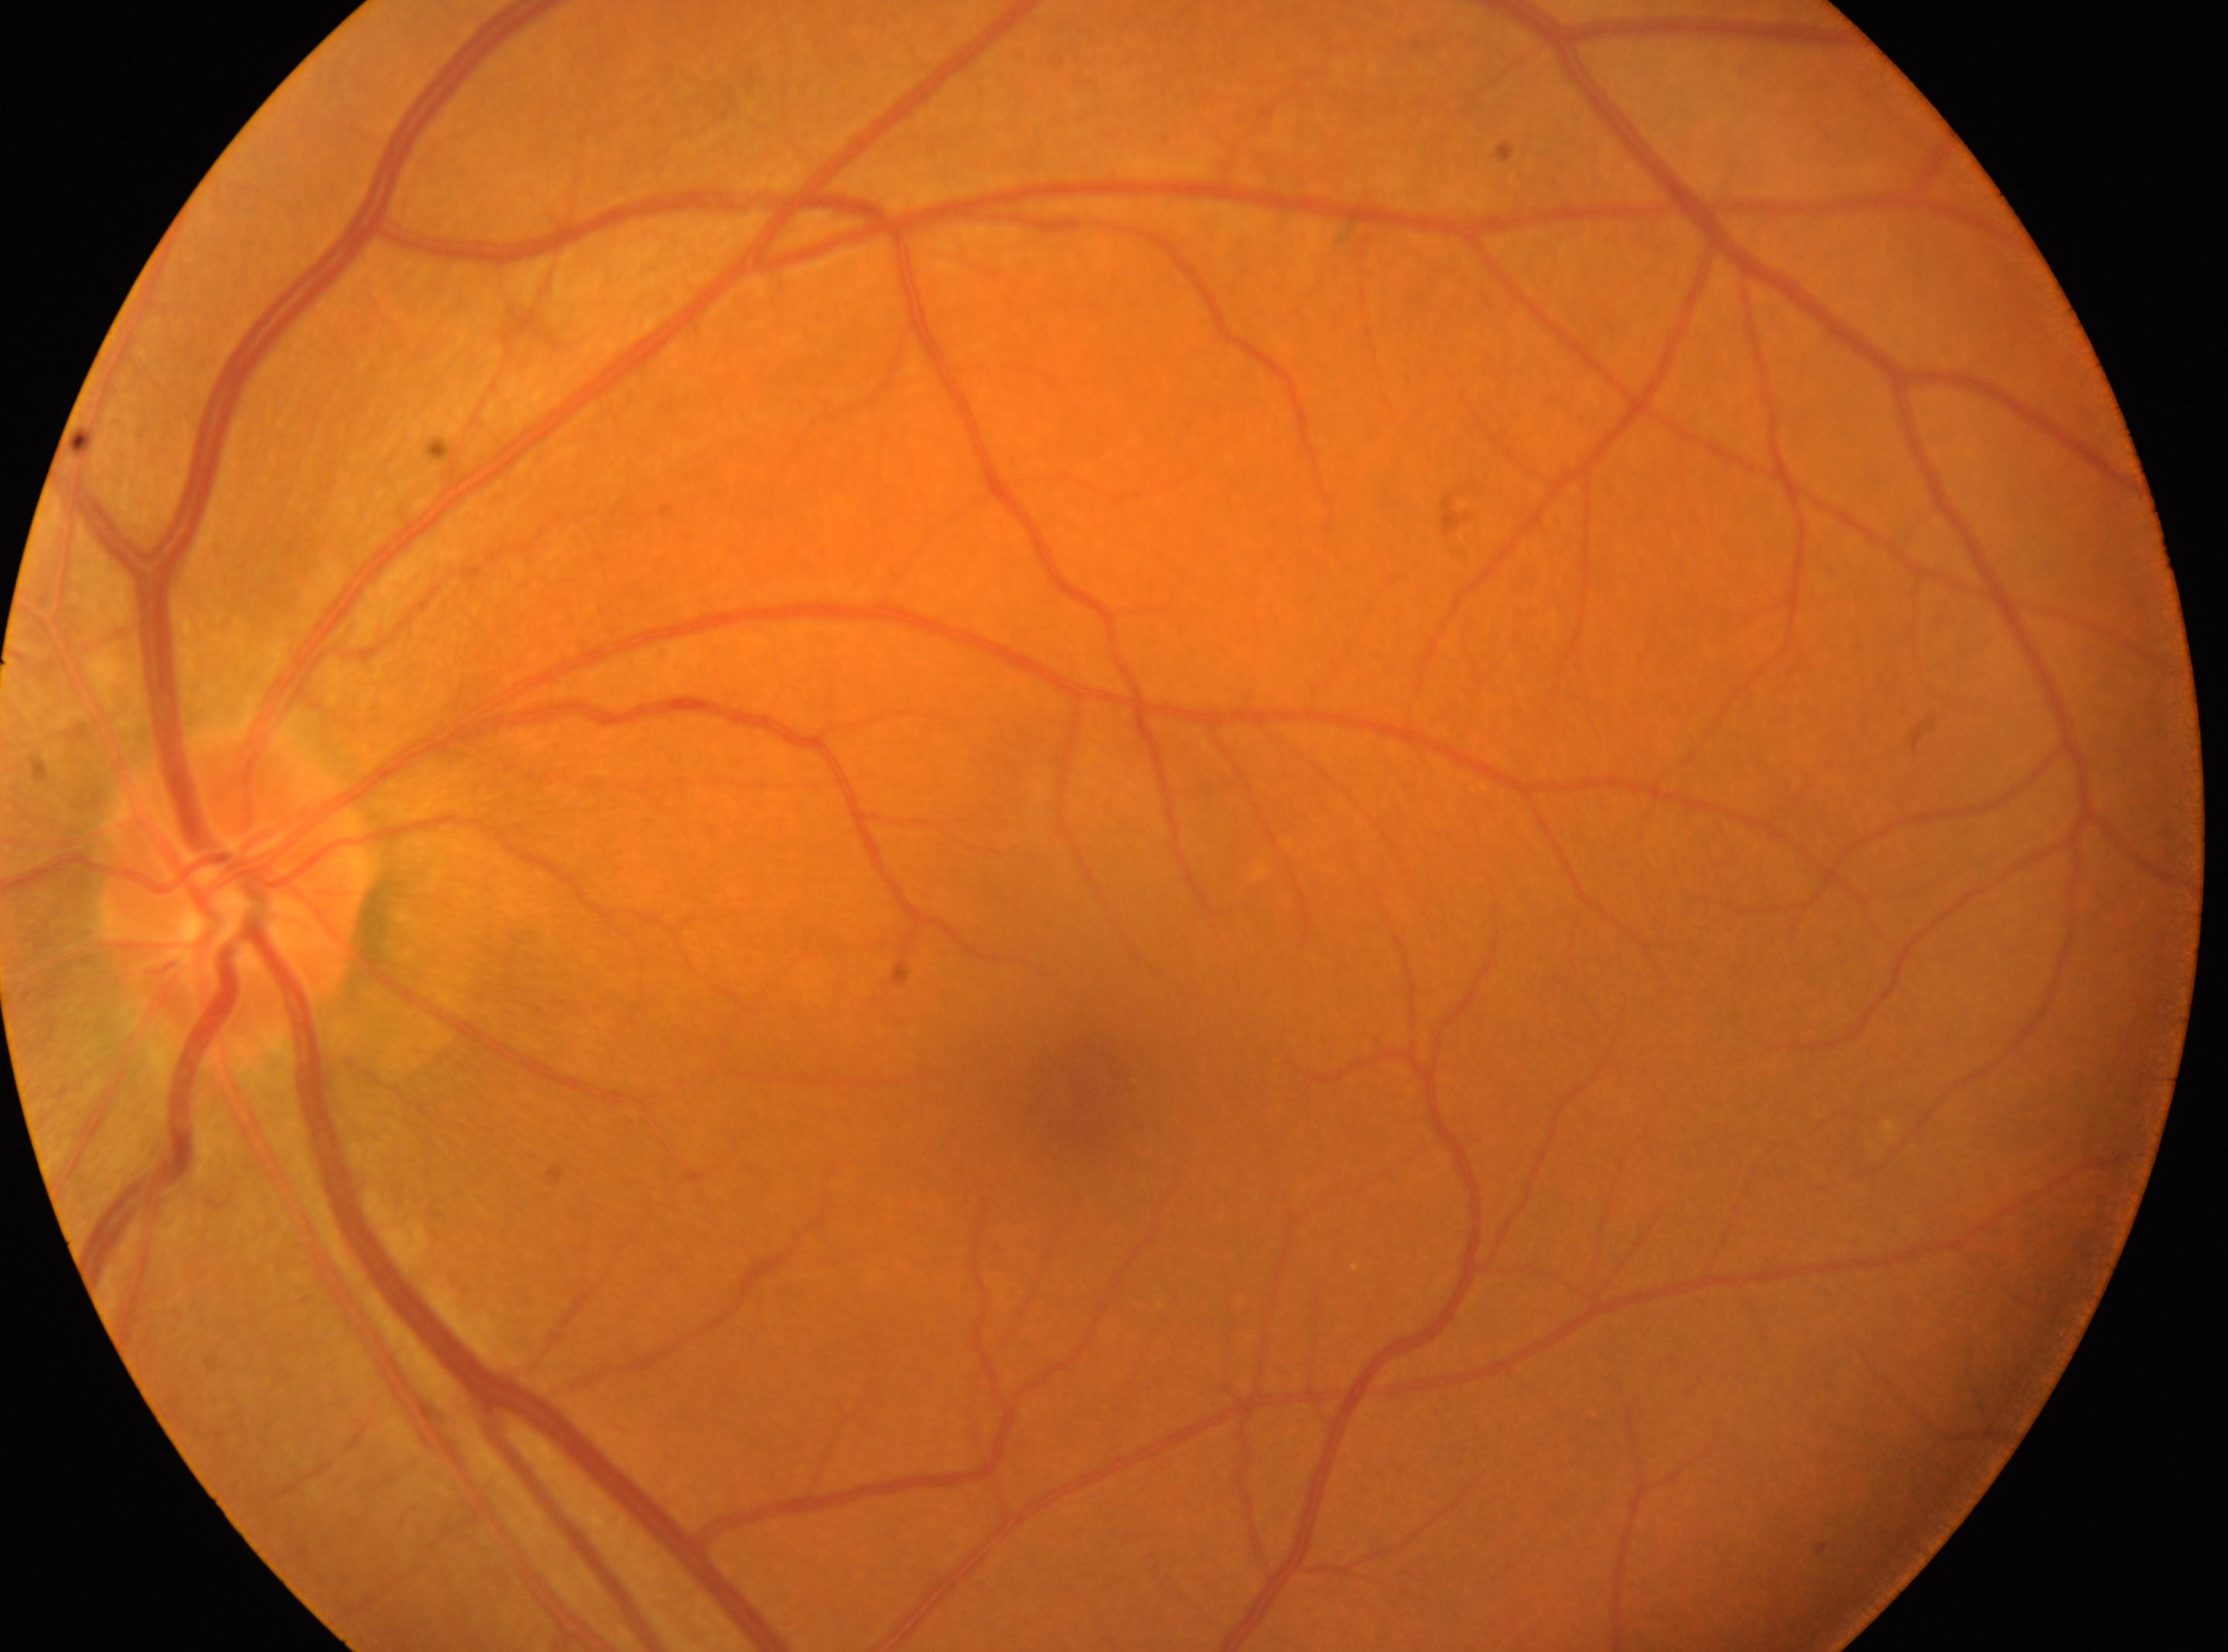
The image shows the left eye.
DR stage: no apparent retinopathy (grade 0).
The foveal center is at (x: 1080, y: 1091).
Optic disk located at (x: 233, y: 893).